848x848px.
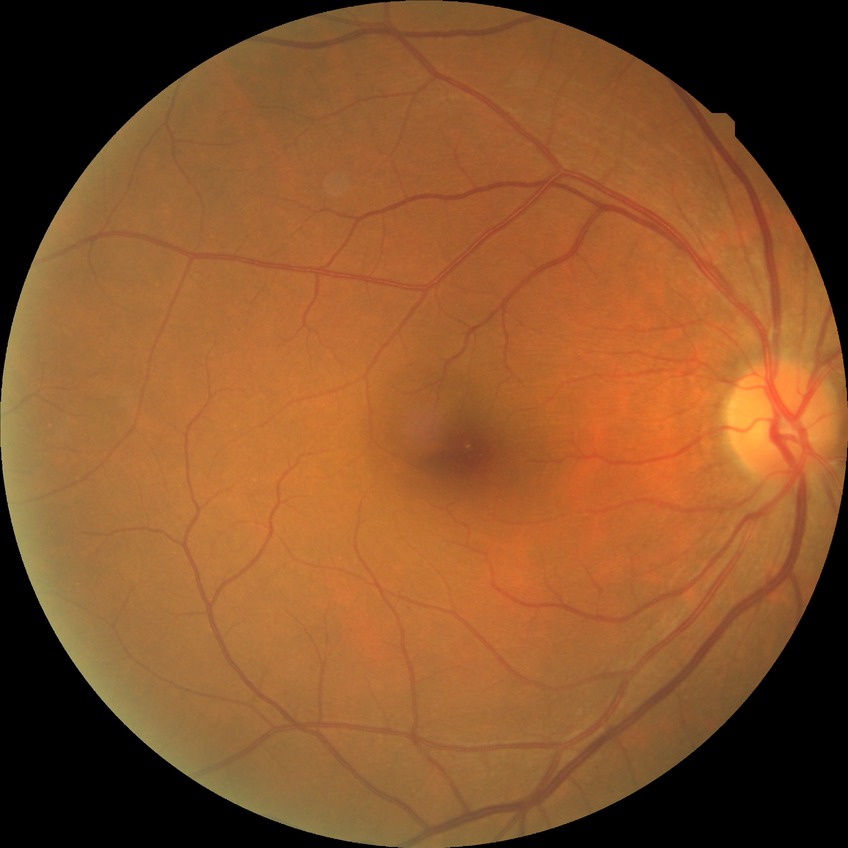

Assessment:
- diabetic retinopathy stage: no diabetic retinopathy